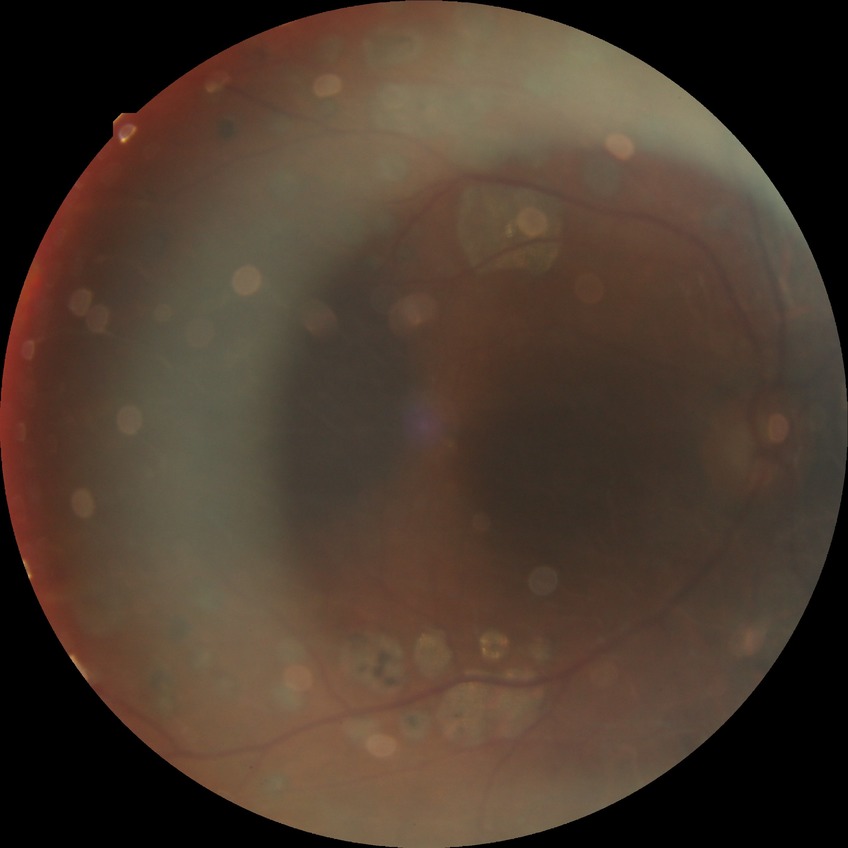
Davis grade@PDR.